2048 x 1536 pixels.
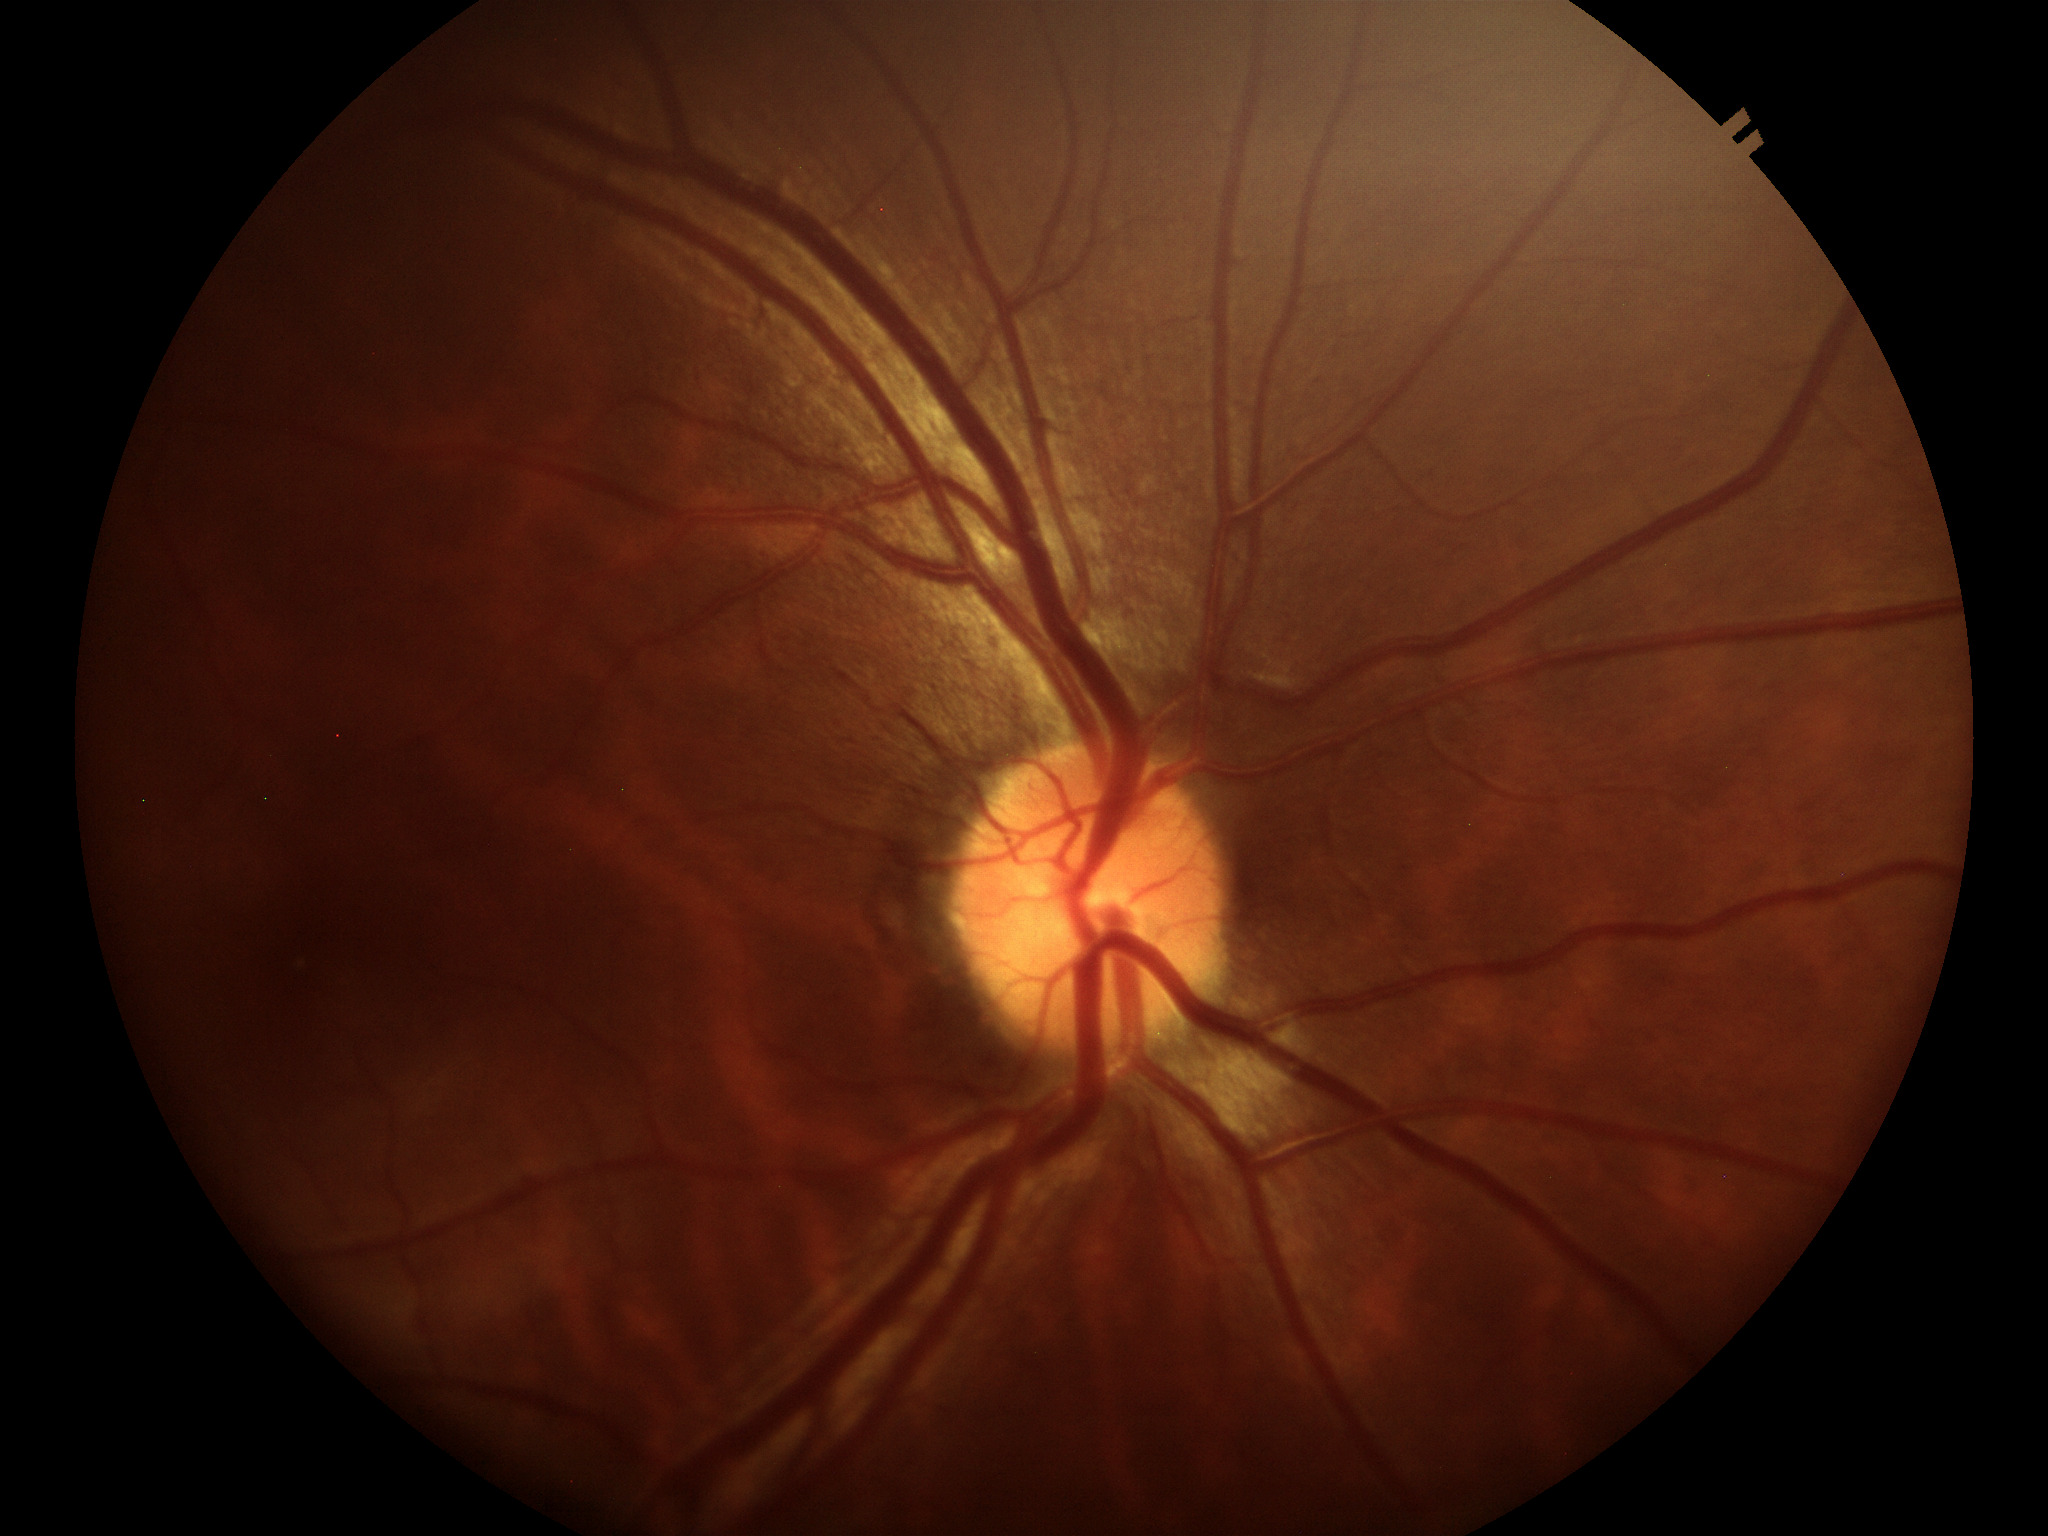
Annotations:
• Glaucoma impression: negative (all 5 graders called normal)
• VCDR: 0.41